Wide-field fundus photograph from neonatal ROP screening; camera: Clarity RetCam 3 (130° FOV); 640x480:
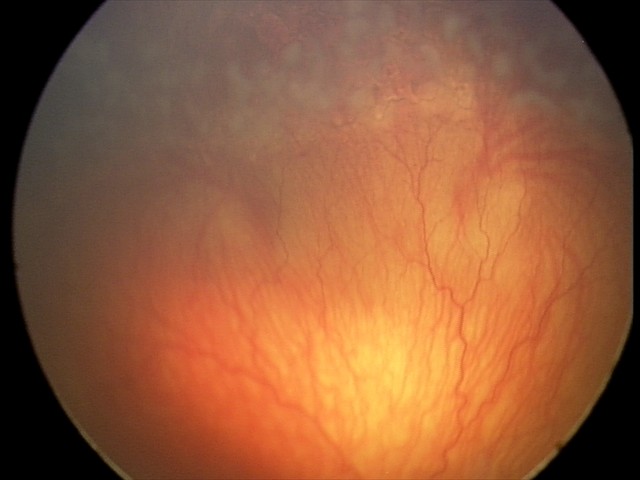
Examination diagnosed as aggressive retinopathy of prematurity (A-ROP).